No pharmacologic dilation.
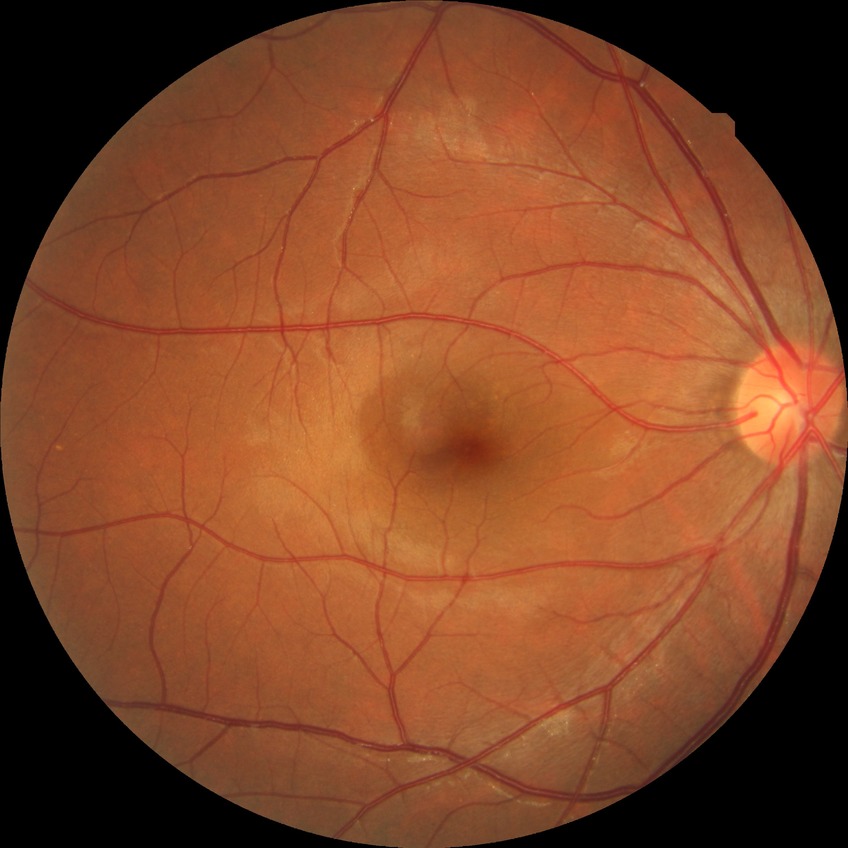 Modified Davis grading is no diabetic retinopathy.